45° FOV
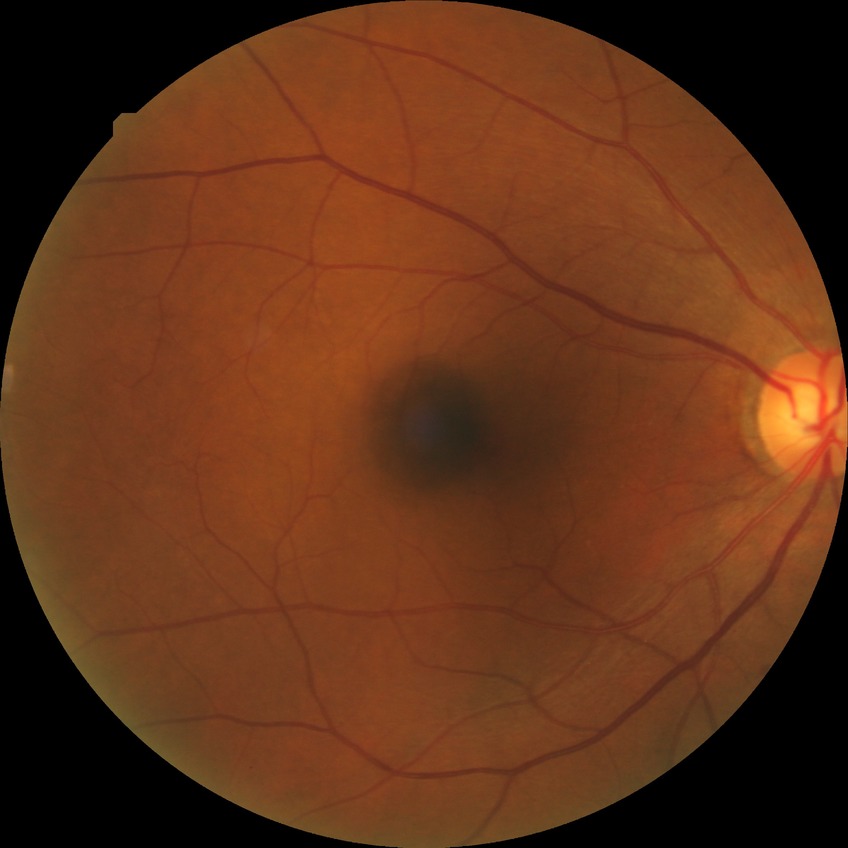
  proliferative_class: non-proliferative diabetic retinopathy
  davis_grade: SDR